848x848; 45° FOV; posterior pole photograph
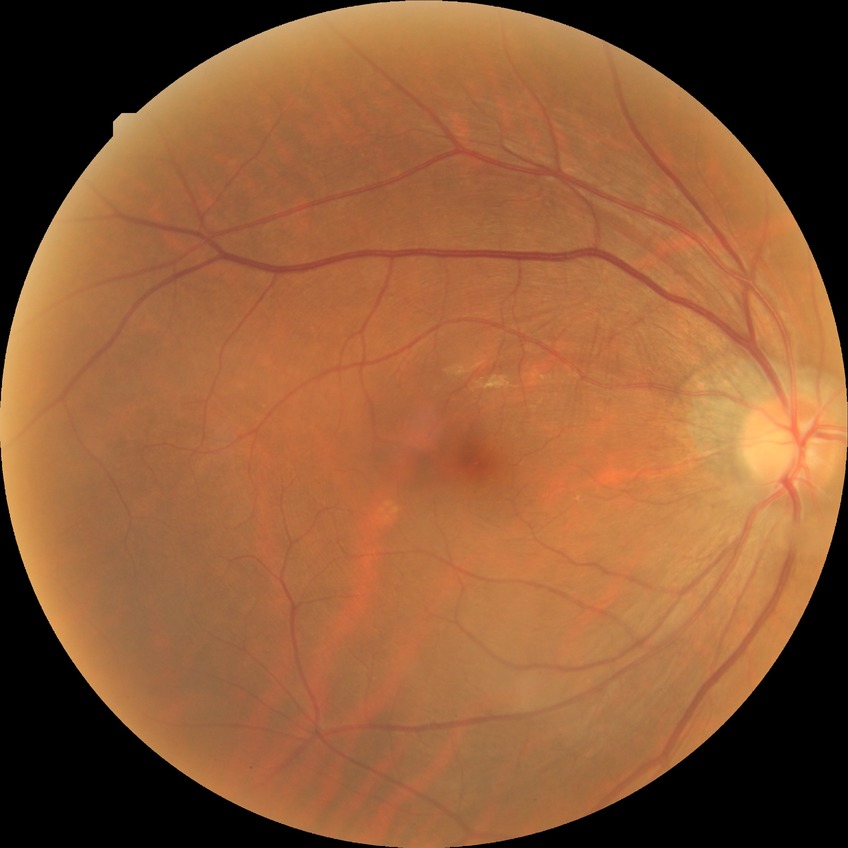
retinopathy grade=no diabetic retinopathy.